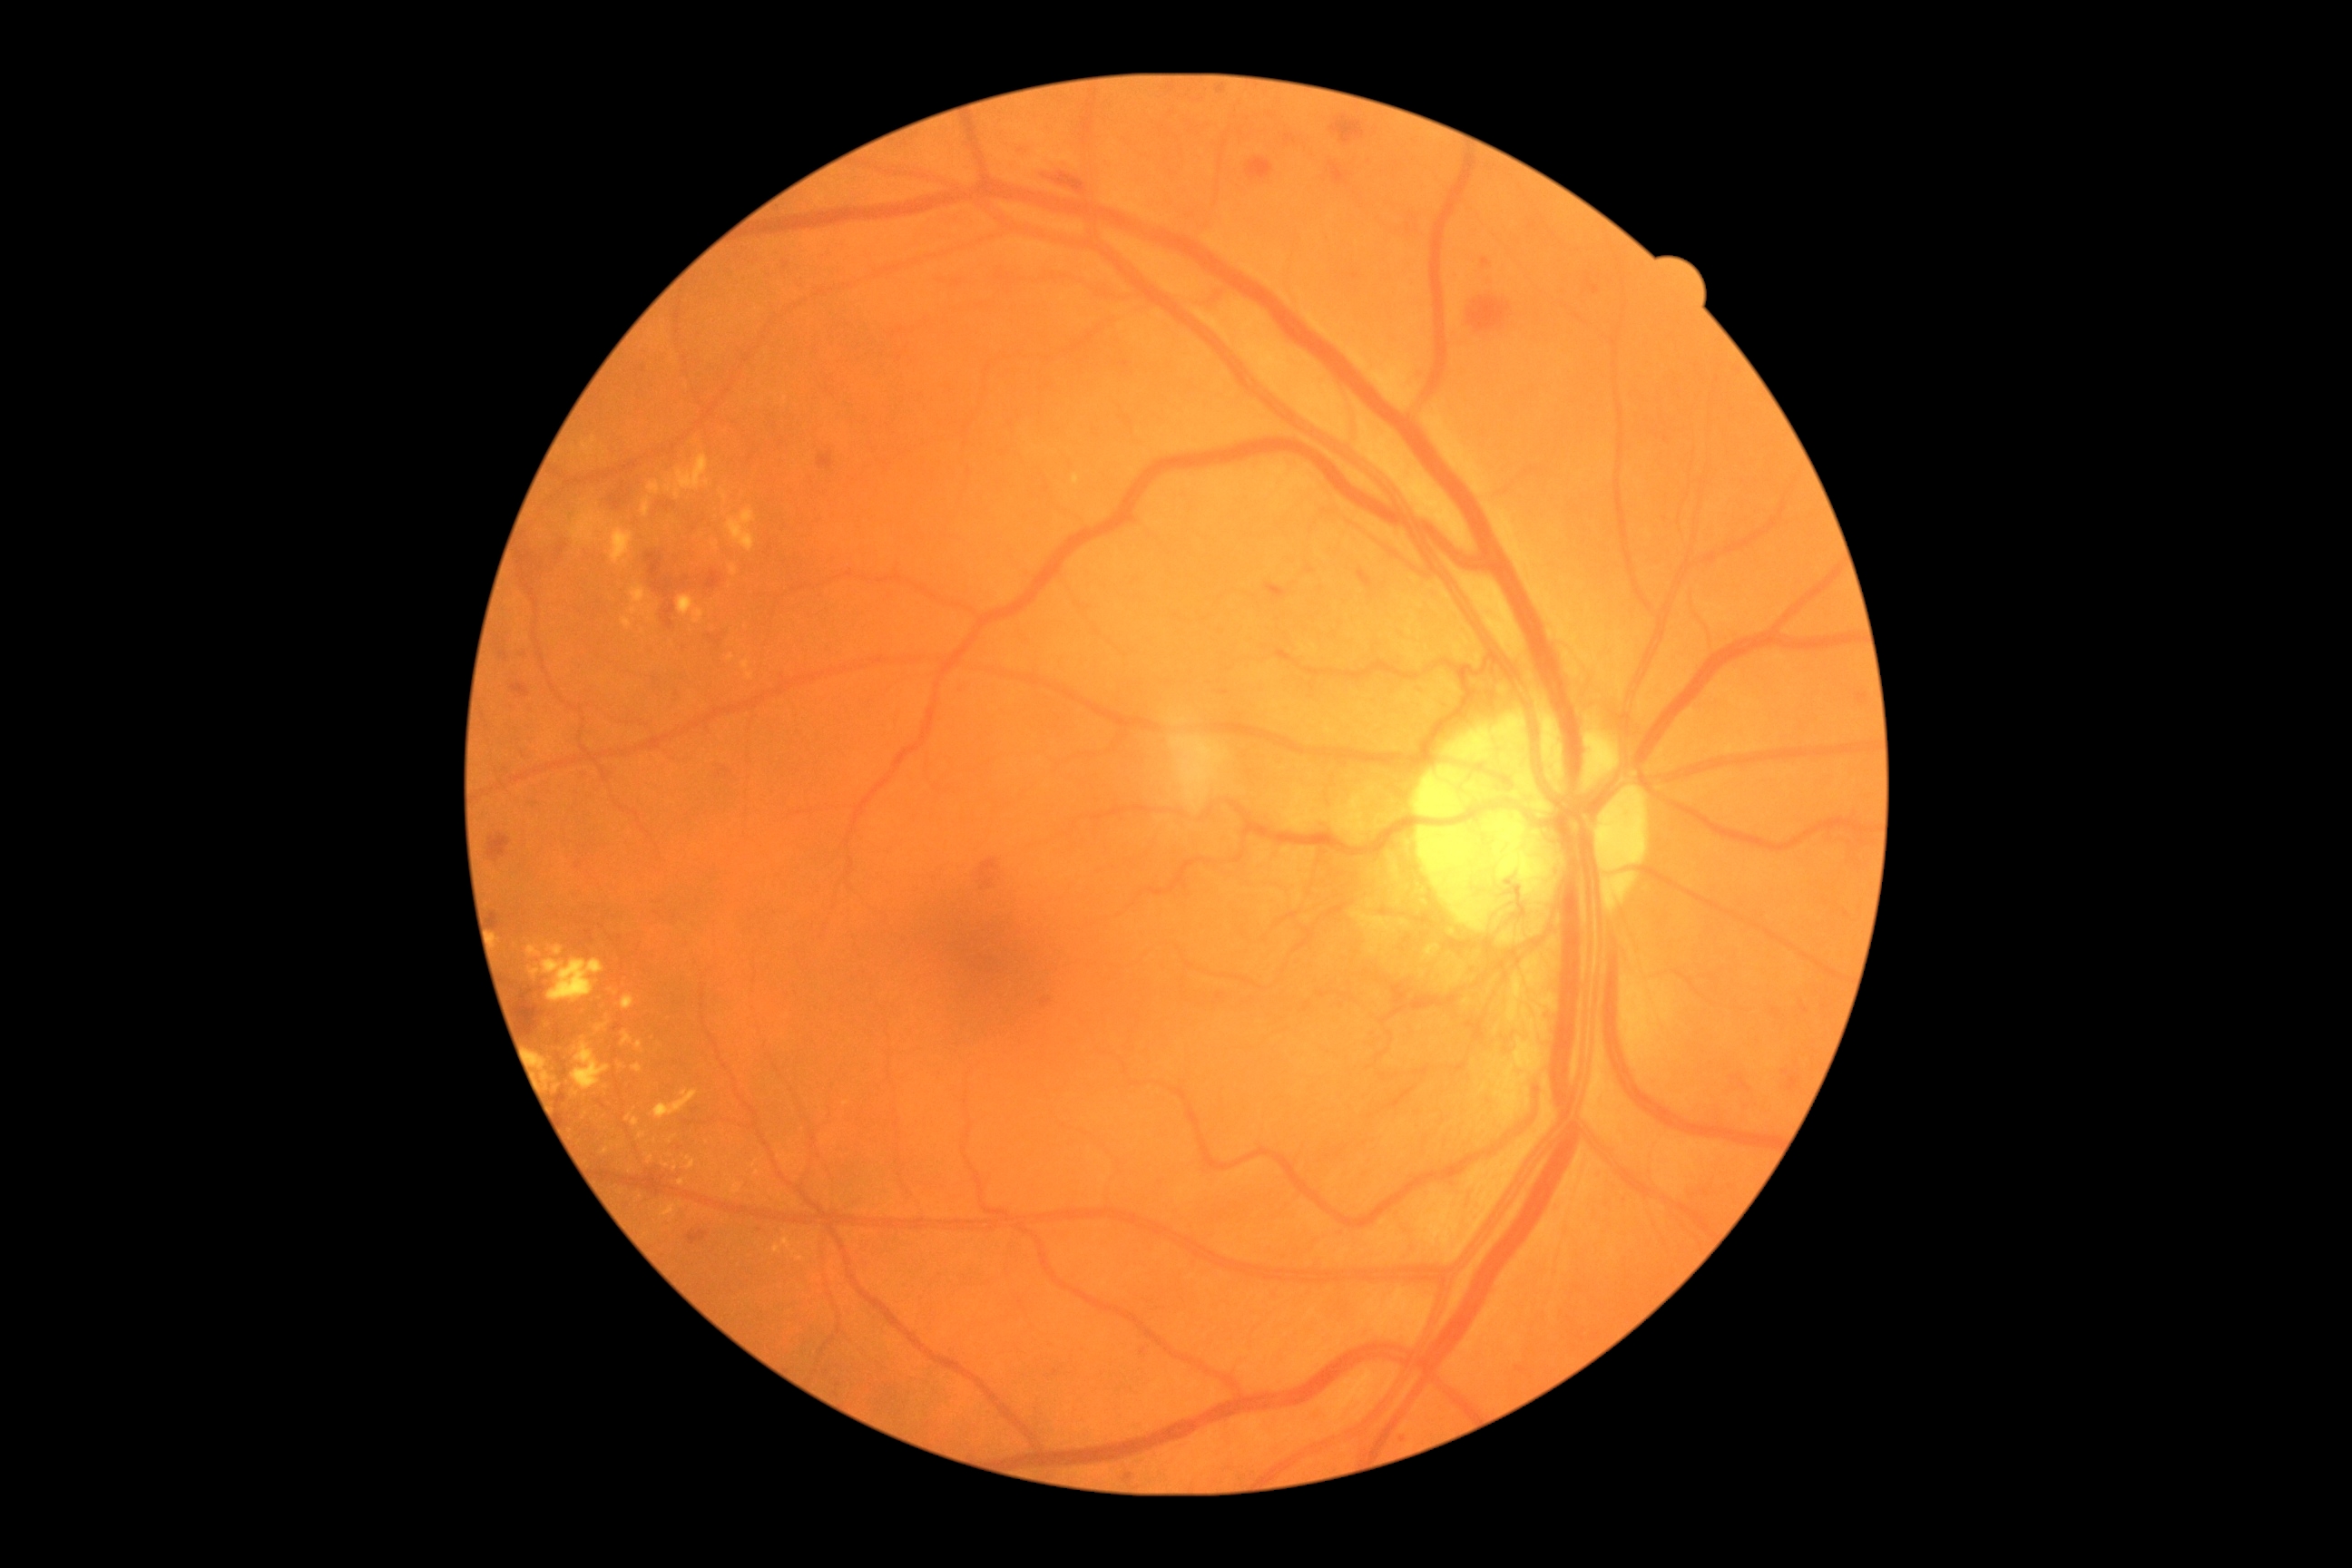
Diabetic retinopathy grade is 4. Hard exudates include lesions at 542,959,605,1003 | 611,529,634,565 | 622,1032,632,1046 | 662,1202,683,1217 | 544,1072,551,1083 | 732,1182,743,1195 | 534,1054,547,1072 | 647,1155,654,1164 | 727,509,756,553 | 632,1064,642,1073 | 596,1024,607,1034 | 602,1148,611,1155. Additional small hard exudates near (758; 1174) | (750; 677) | (672; 1139) | (780; 1158) | (801; 1259) | (725; 498) | (707; 483). Hemorrhages include lesions at 493,912,498,930 | 1469,299,1511,333 | 1044,172,1086,195 | 1329,162,1348,186 | 1220,692,1230,696 | 647,553,672,598 | 818,453,834,471 | 495,642,509,663 | 707,569,723,591 | 511,683,531,698 | 979,859,1001,890. No soft exudates identified. Microaneurysms present at 1859,692,1868,700 | 1400,1436,1406,1444 | 1482,259,1491,268 | 1043,999,1052,1006 | 1592,288,1598,299 | 1217,88,1226,95. Additional small microaneurysms near (644; 369) | (1022; 151) | (527; 654) | (761; 1230).